Pediatric wide-field fundus photograph · Phoenix ICON, 100° FOV · 1240x1240px
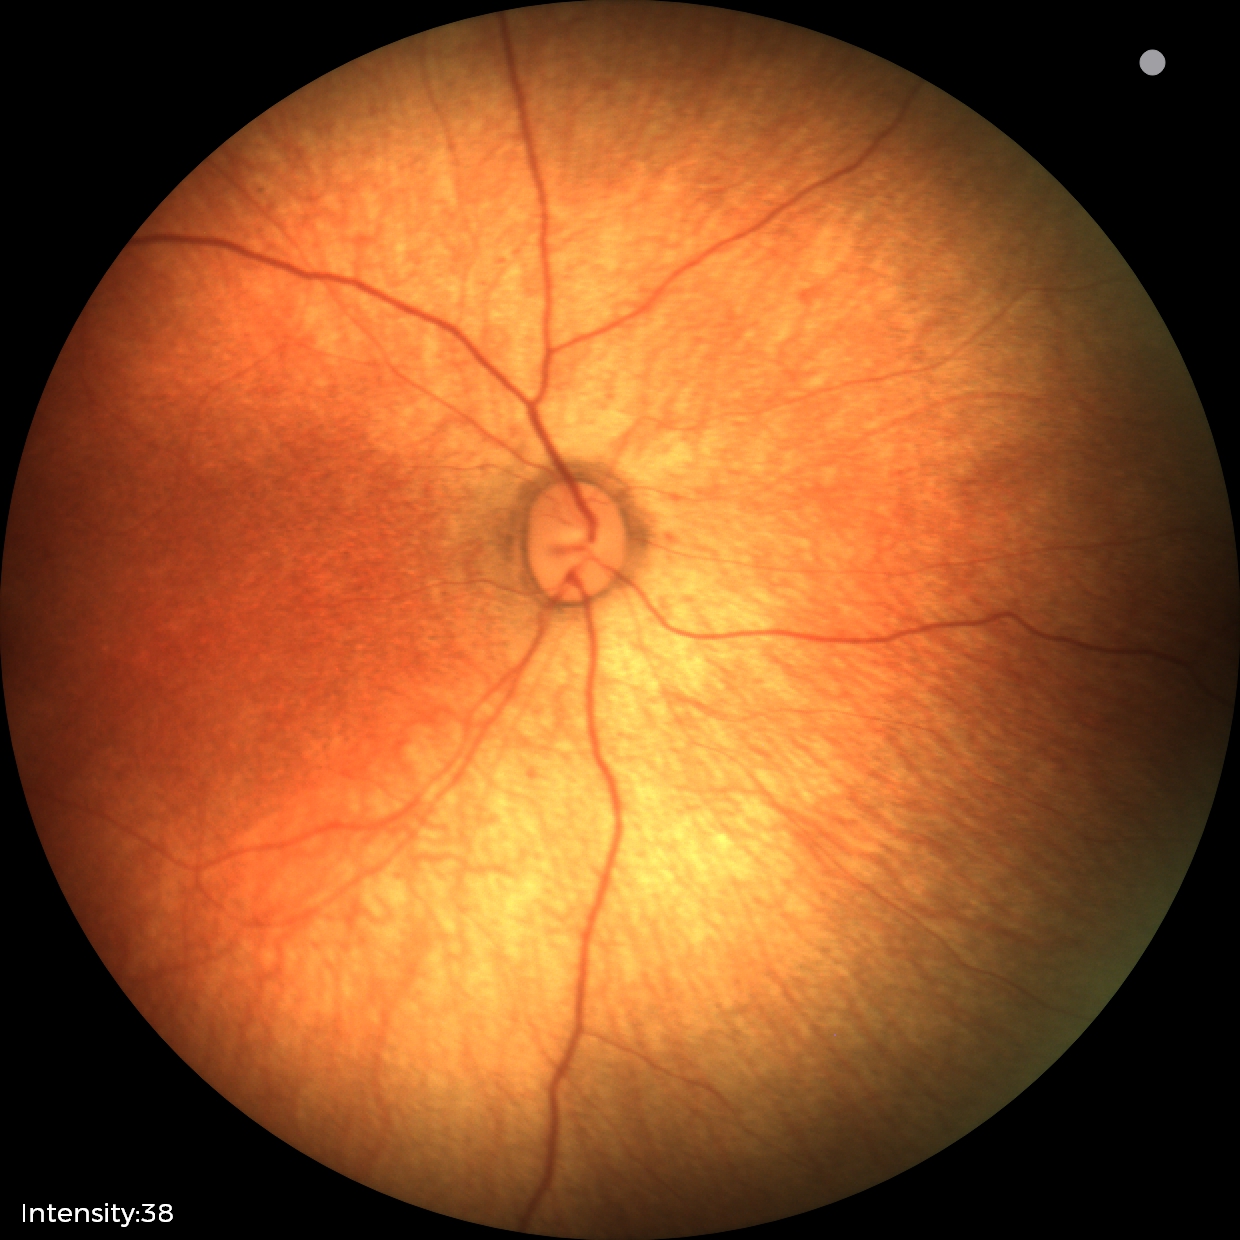

Impression = no pathology identified.